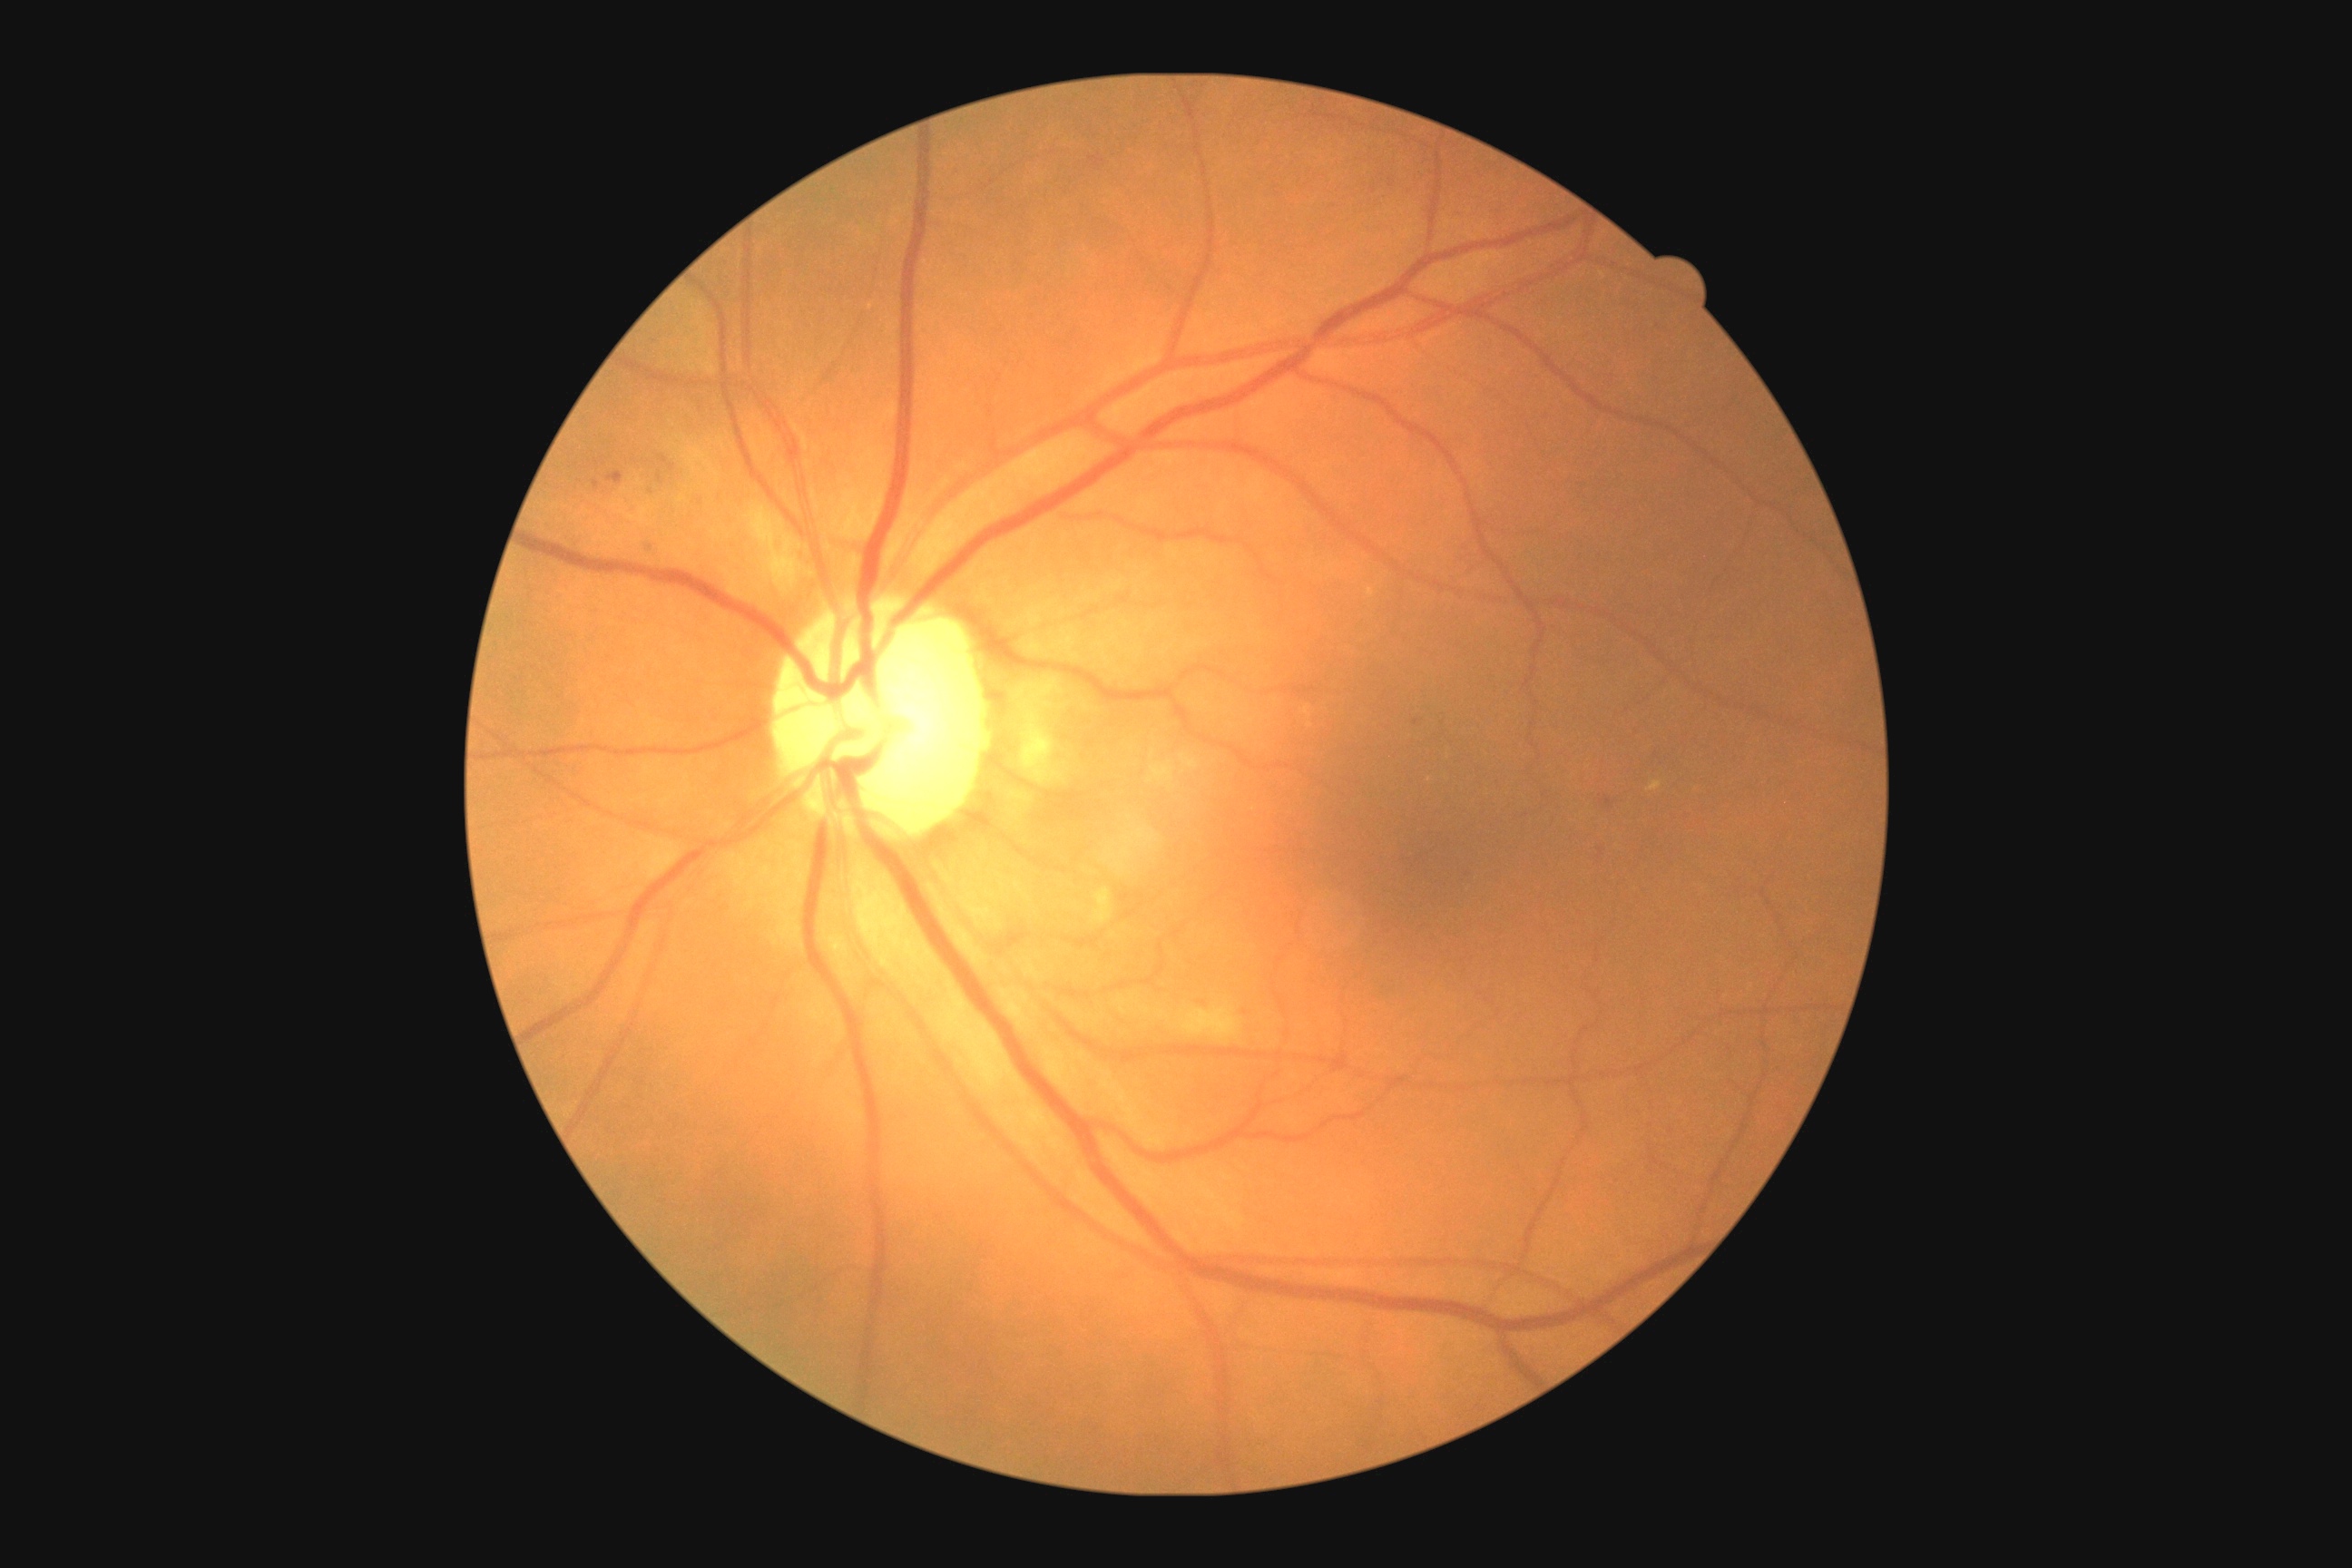
DR is grade 2 (moderate NPDR). DR class: non-proliferative diabetic retinopathy.